Camera: Natus RetCam Envision (130° FOV) · wide-field contact fundus photograph of an infant — 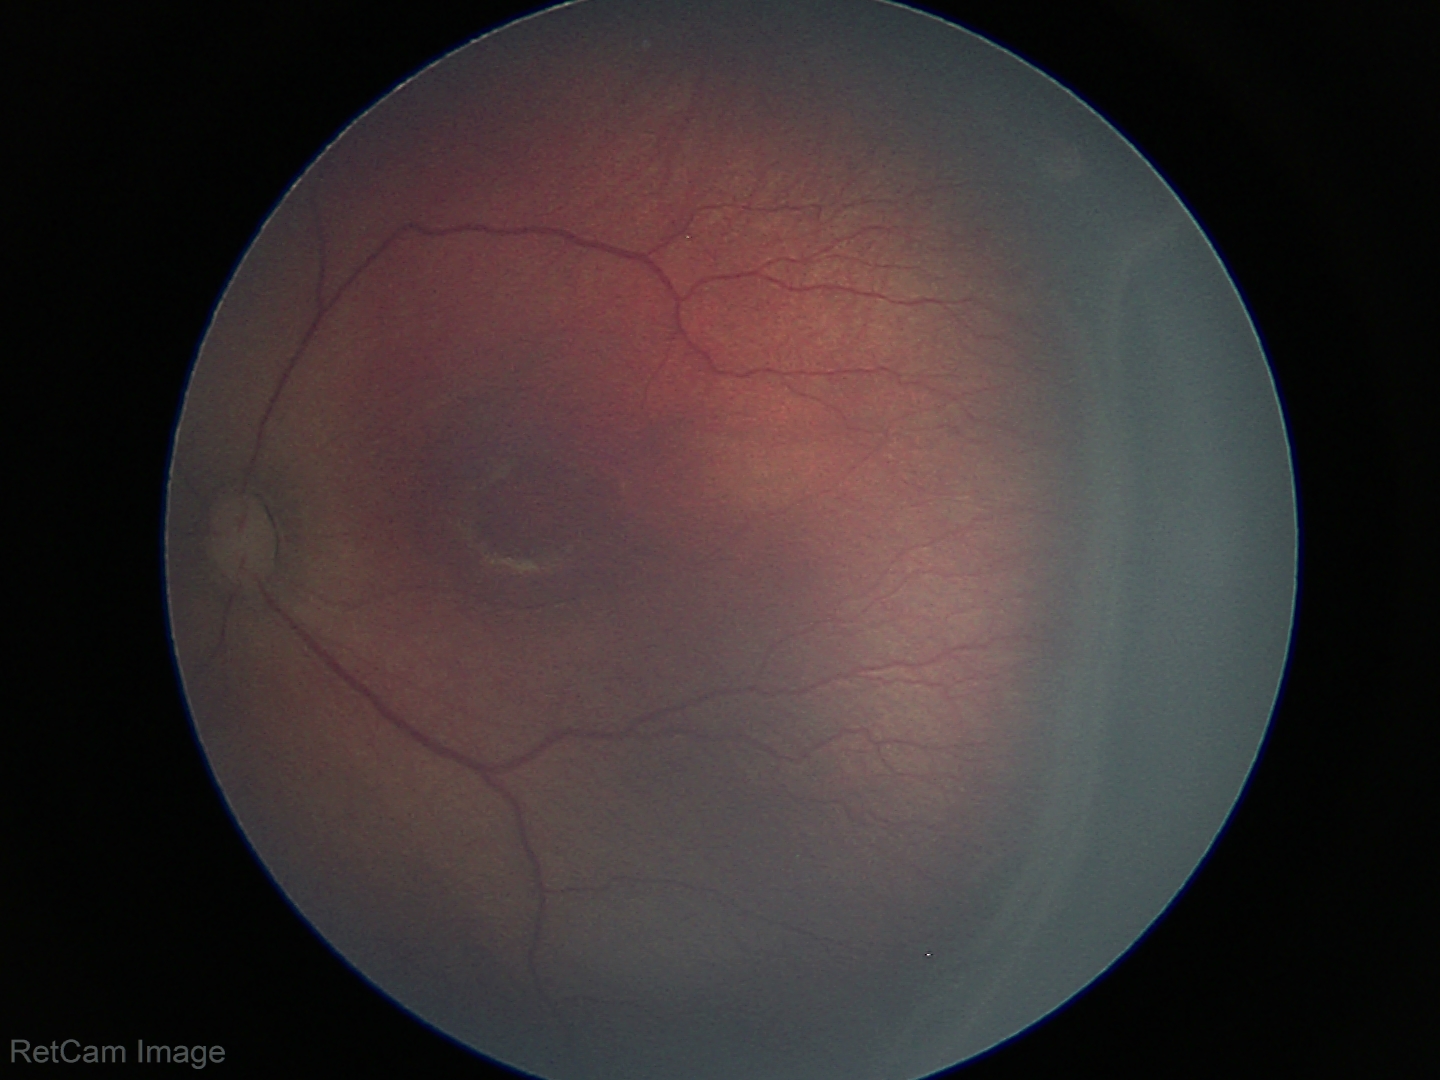
Examination diagnosed as retinopathy of prematurity stage 3.
Plus disease absent.